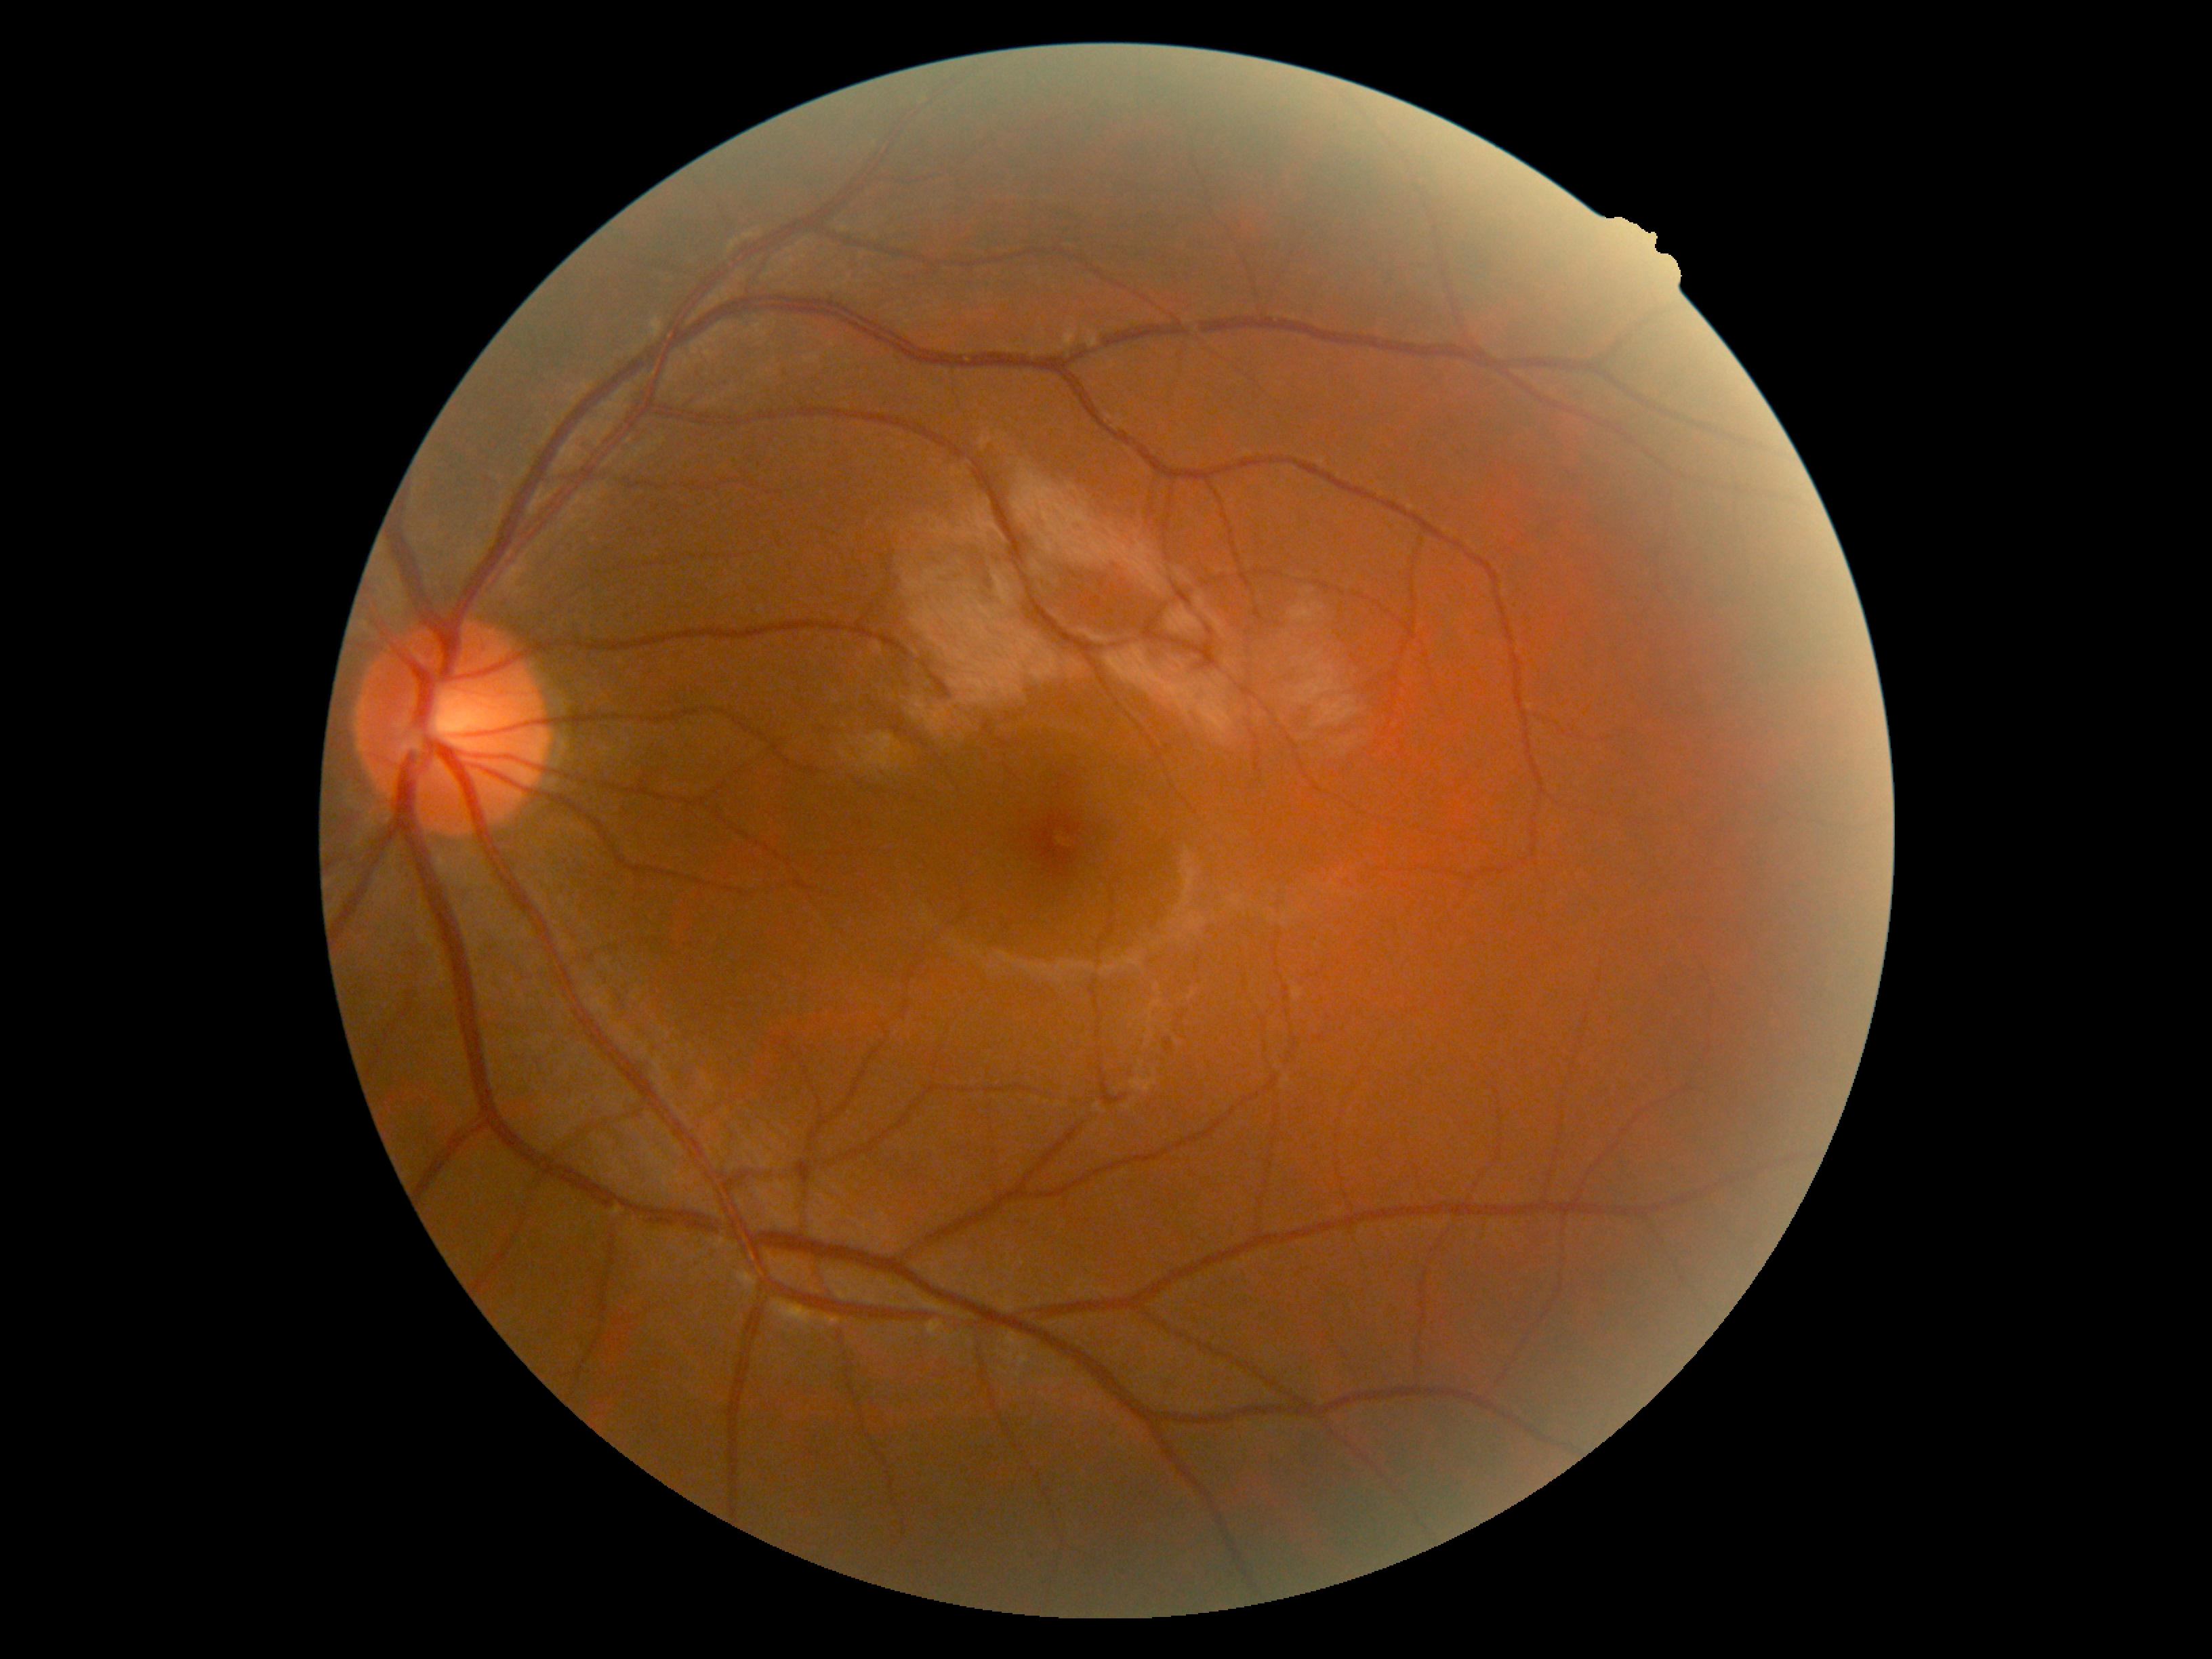
Diabetic retinopathy grade: 0/4. No DR findings.